Acquired on the Phoenix ICON. 1240x1240. Wide-field fundus photograph of an infant.
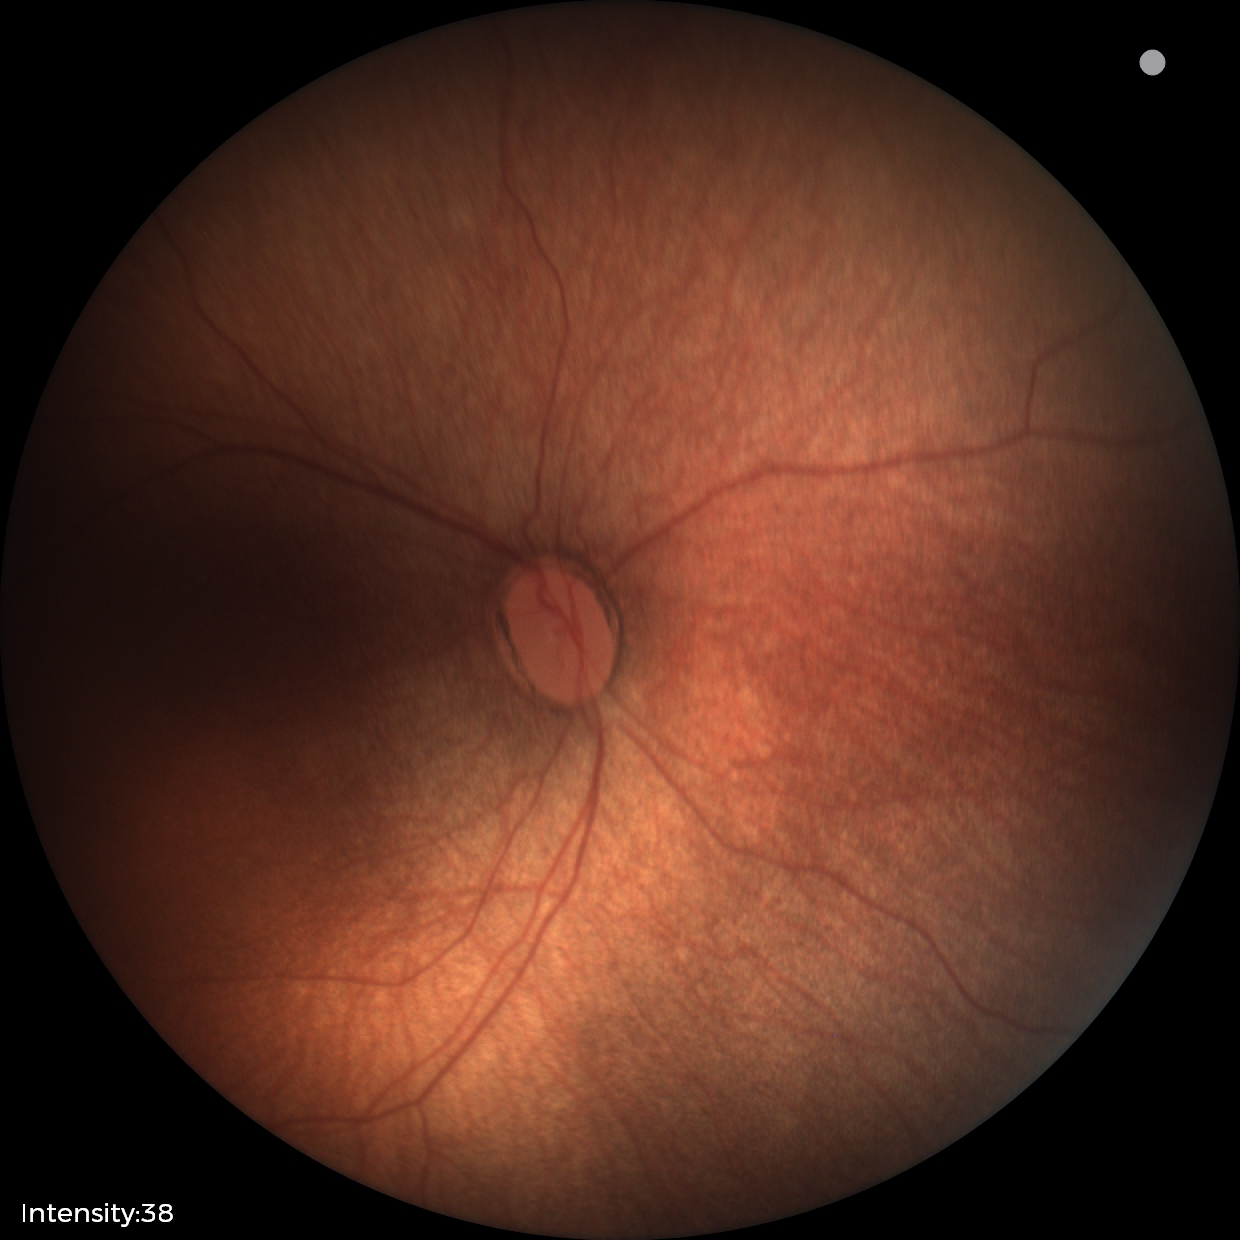

Plus disease: absent
assessment: status post retinopathy of prematurity — retinal appearance after treated retinopathy of prematurity